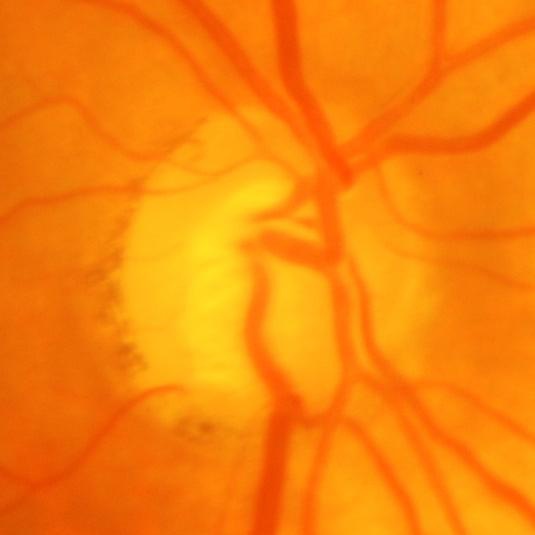

Q: Does this eye have glaucoma?
A: Yes — glaucomatous optic neuropathy.